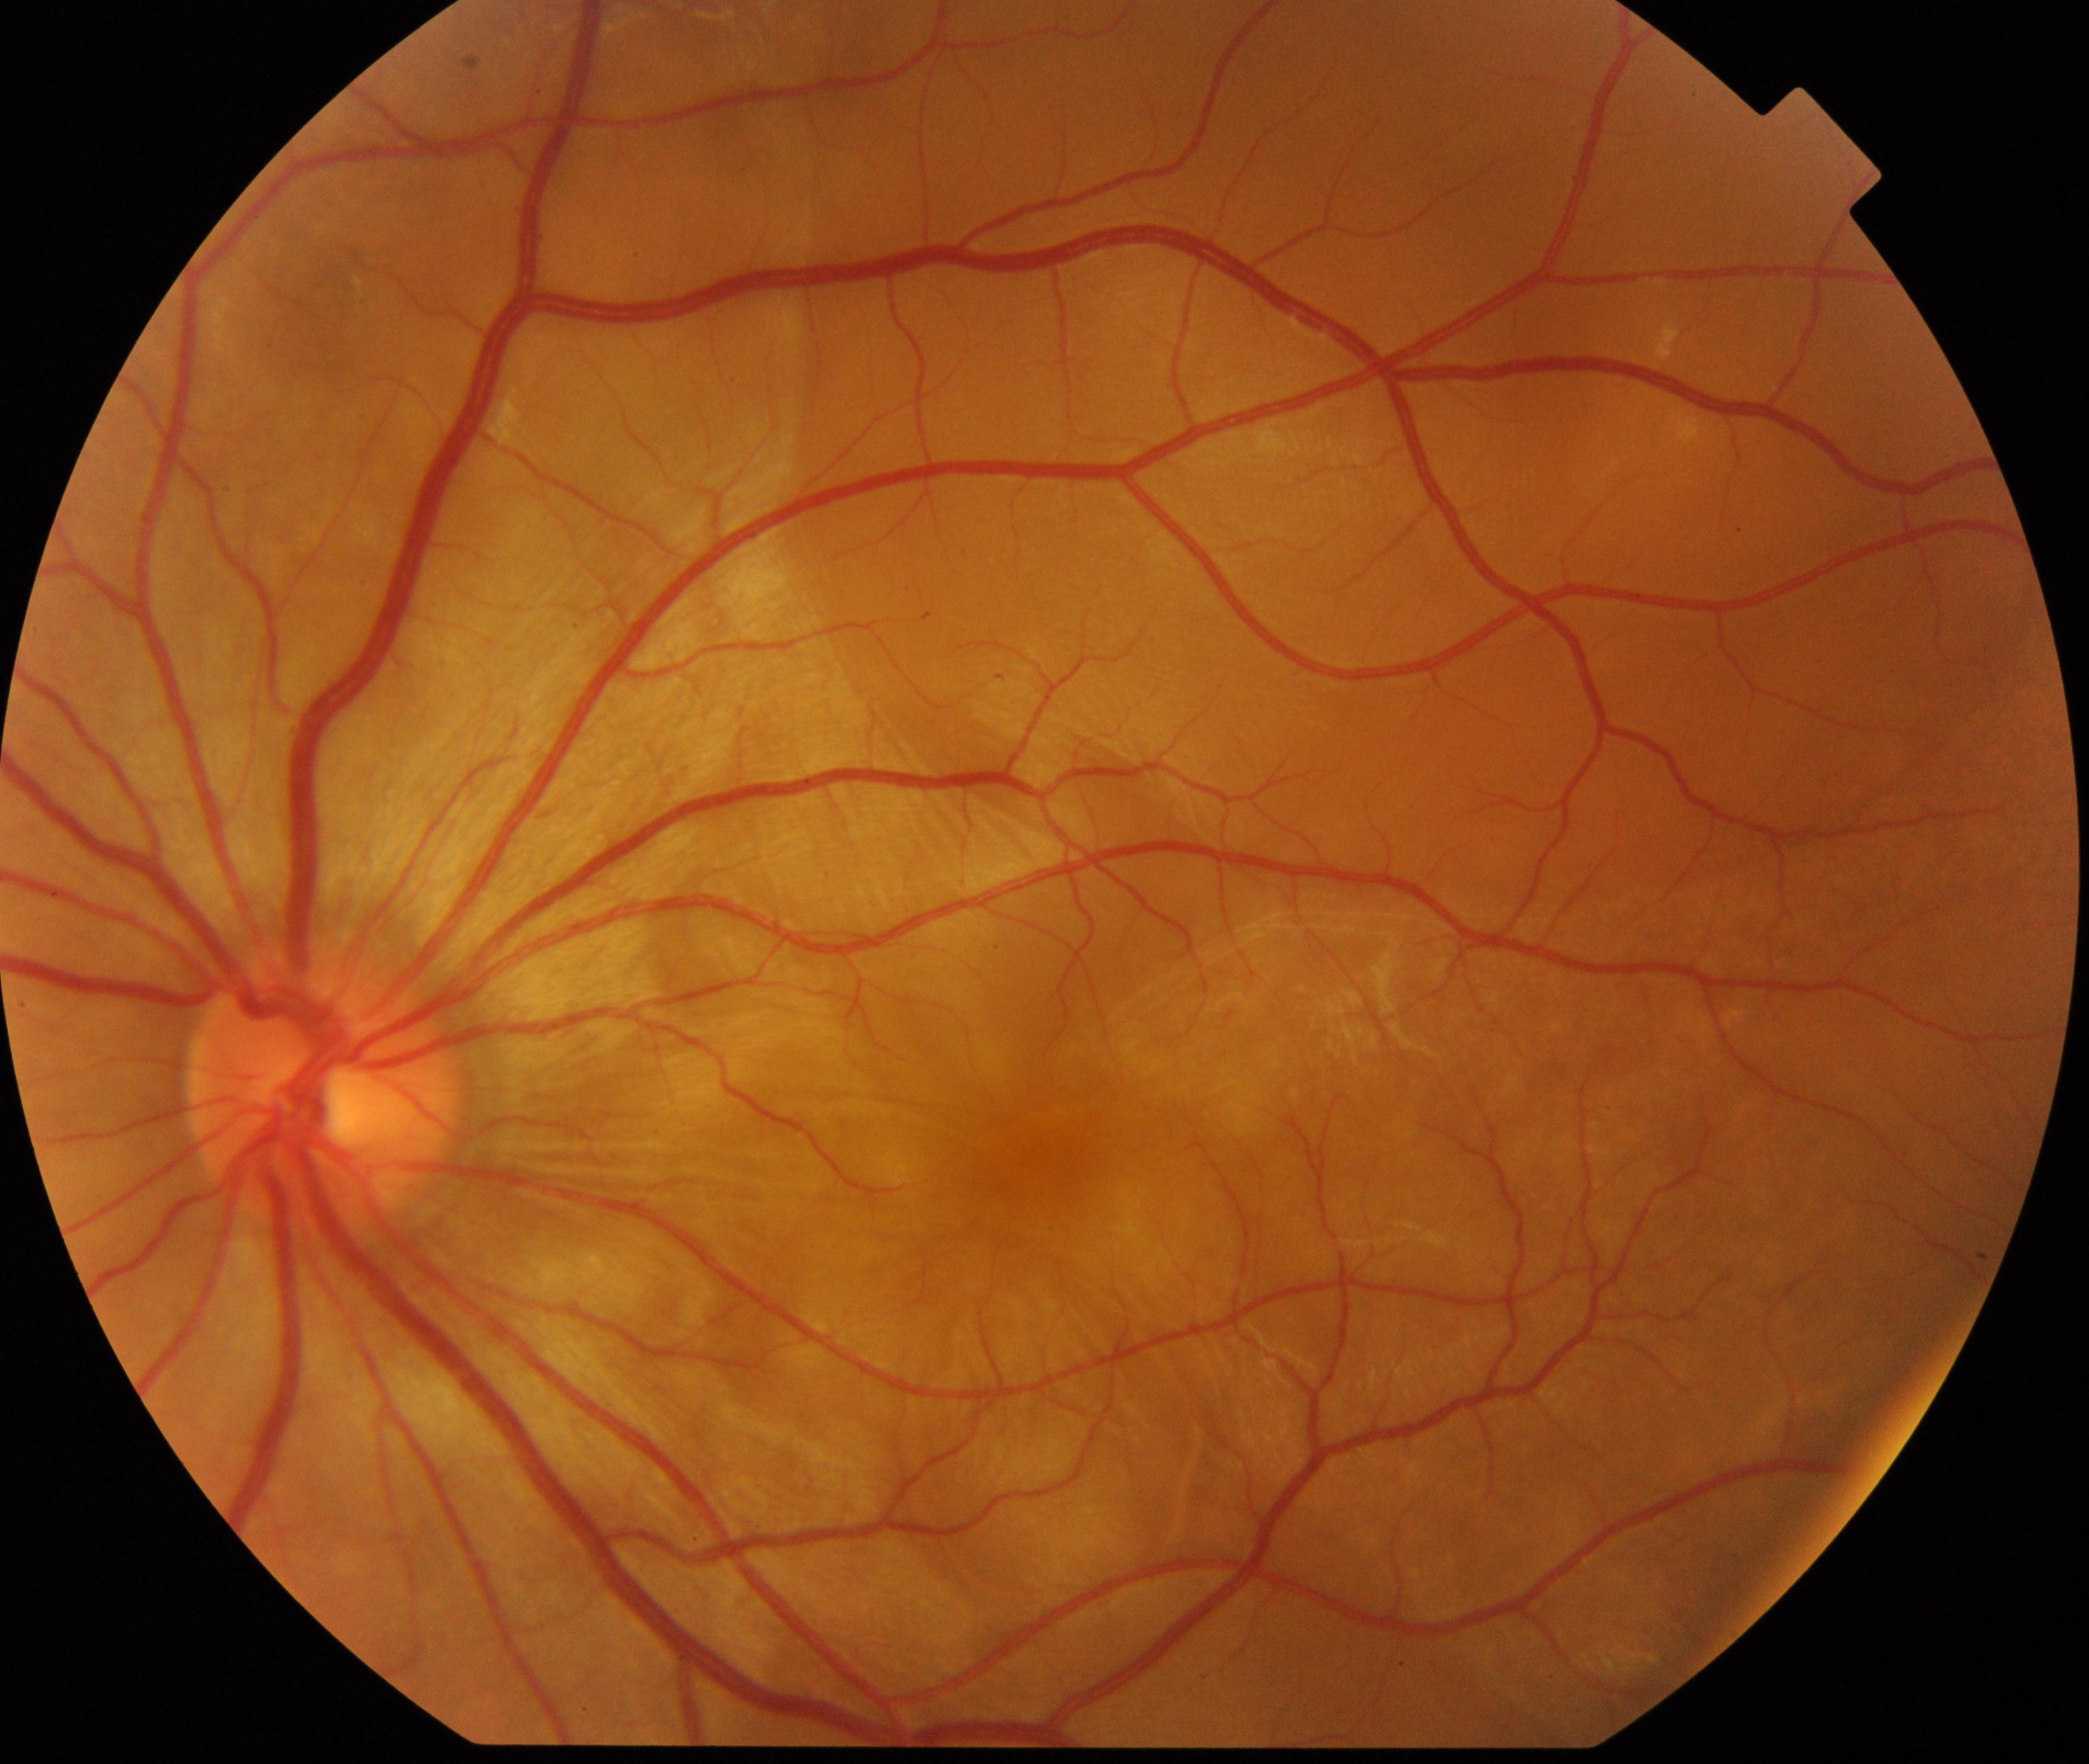

Primary finding: Vogt-Koyanagi-Harada disease.